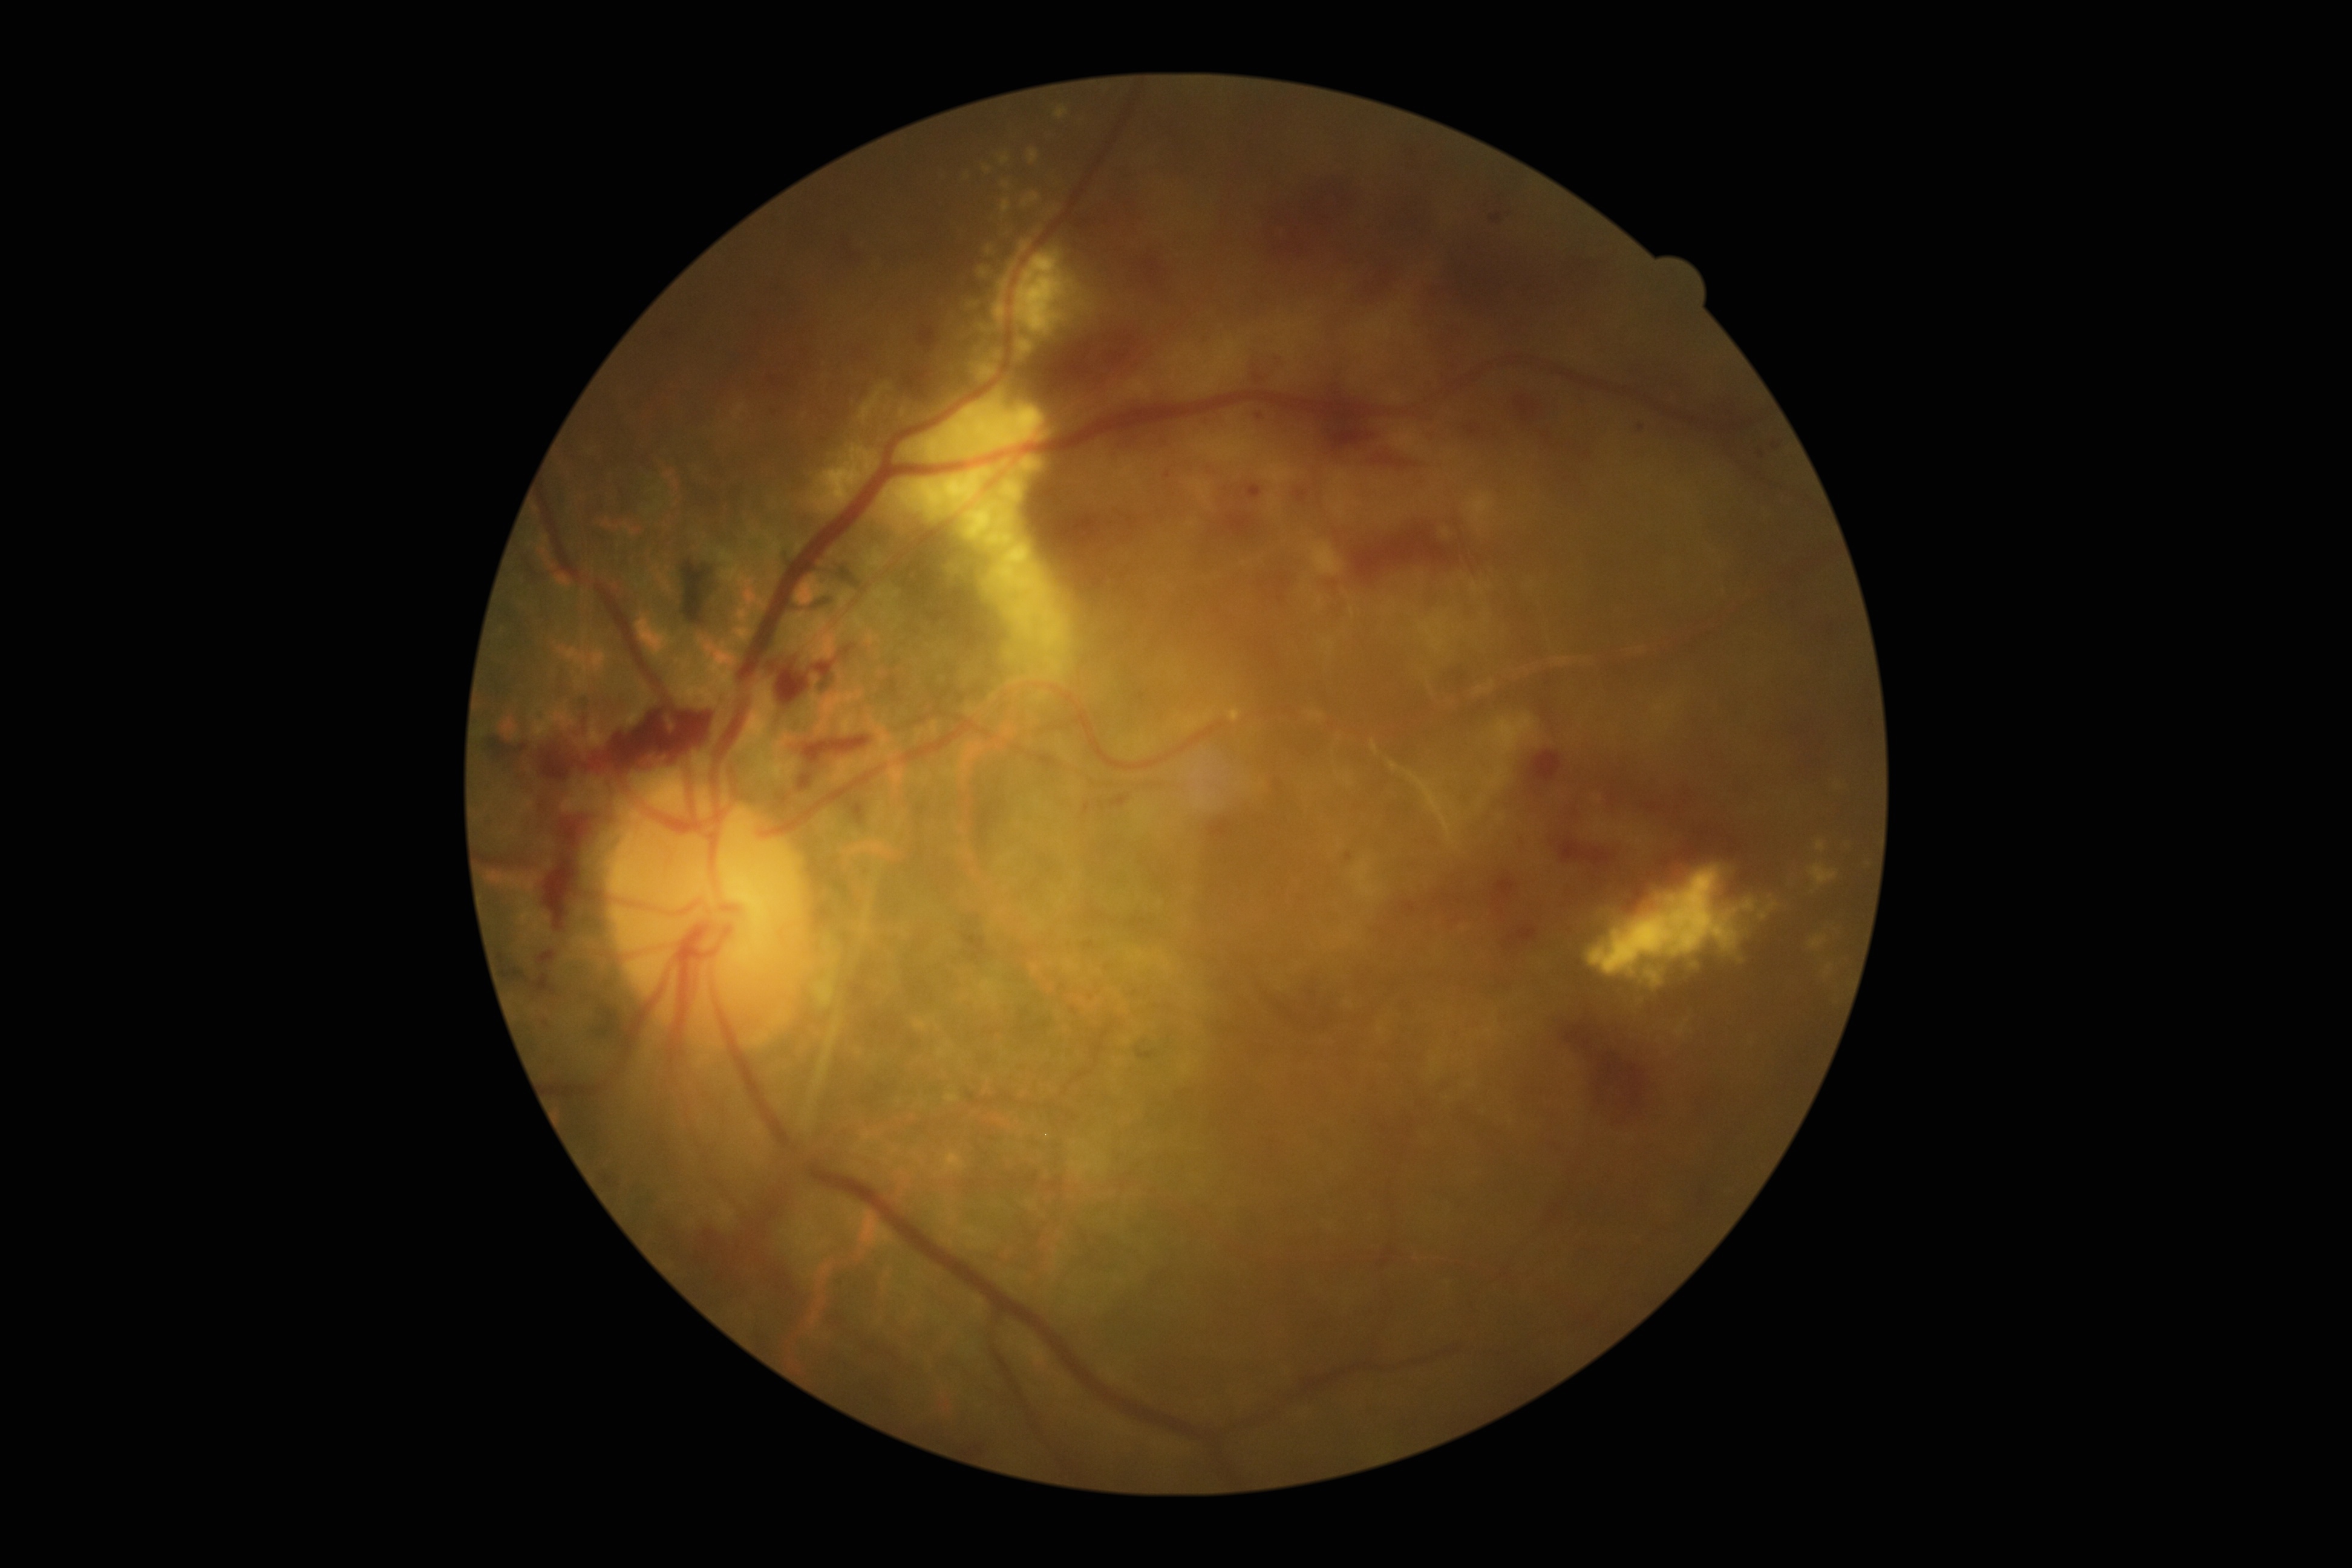 diabetic retinopathy (DR)@PDR (grade 4).